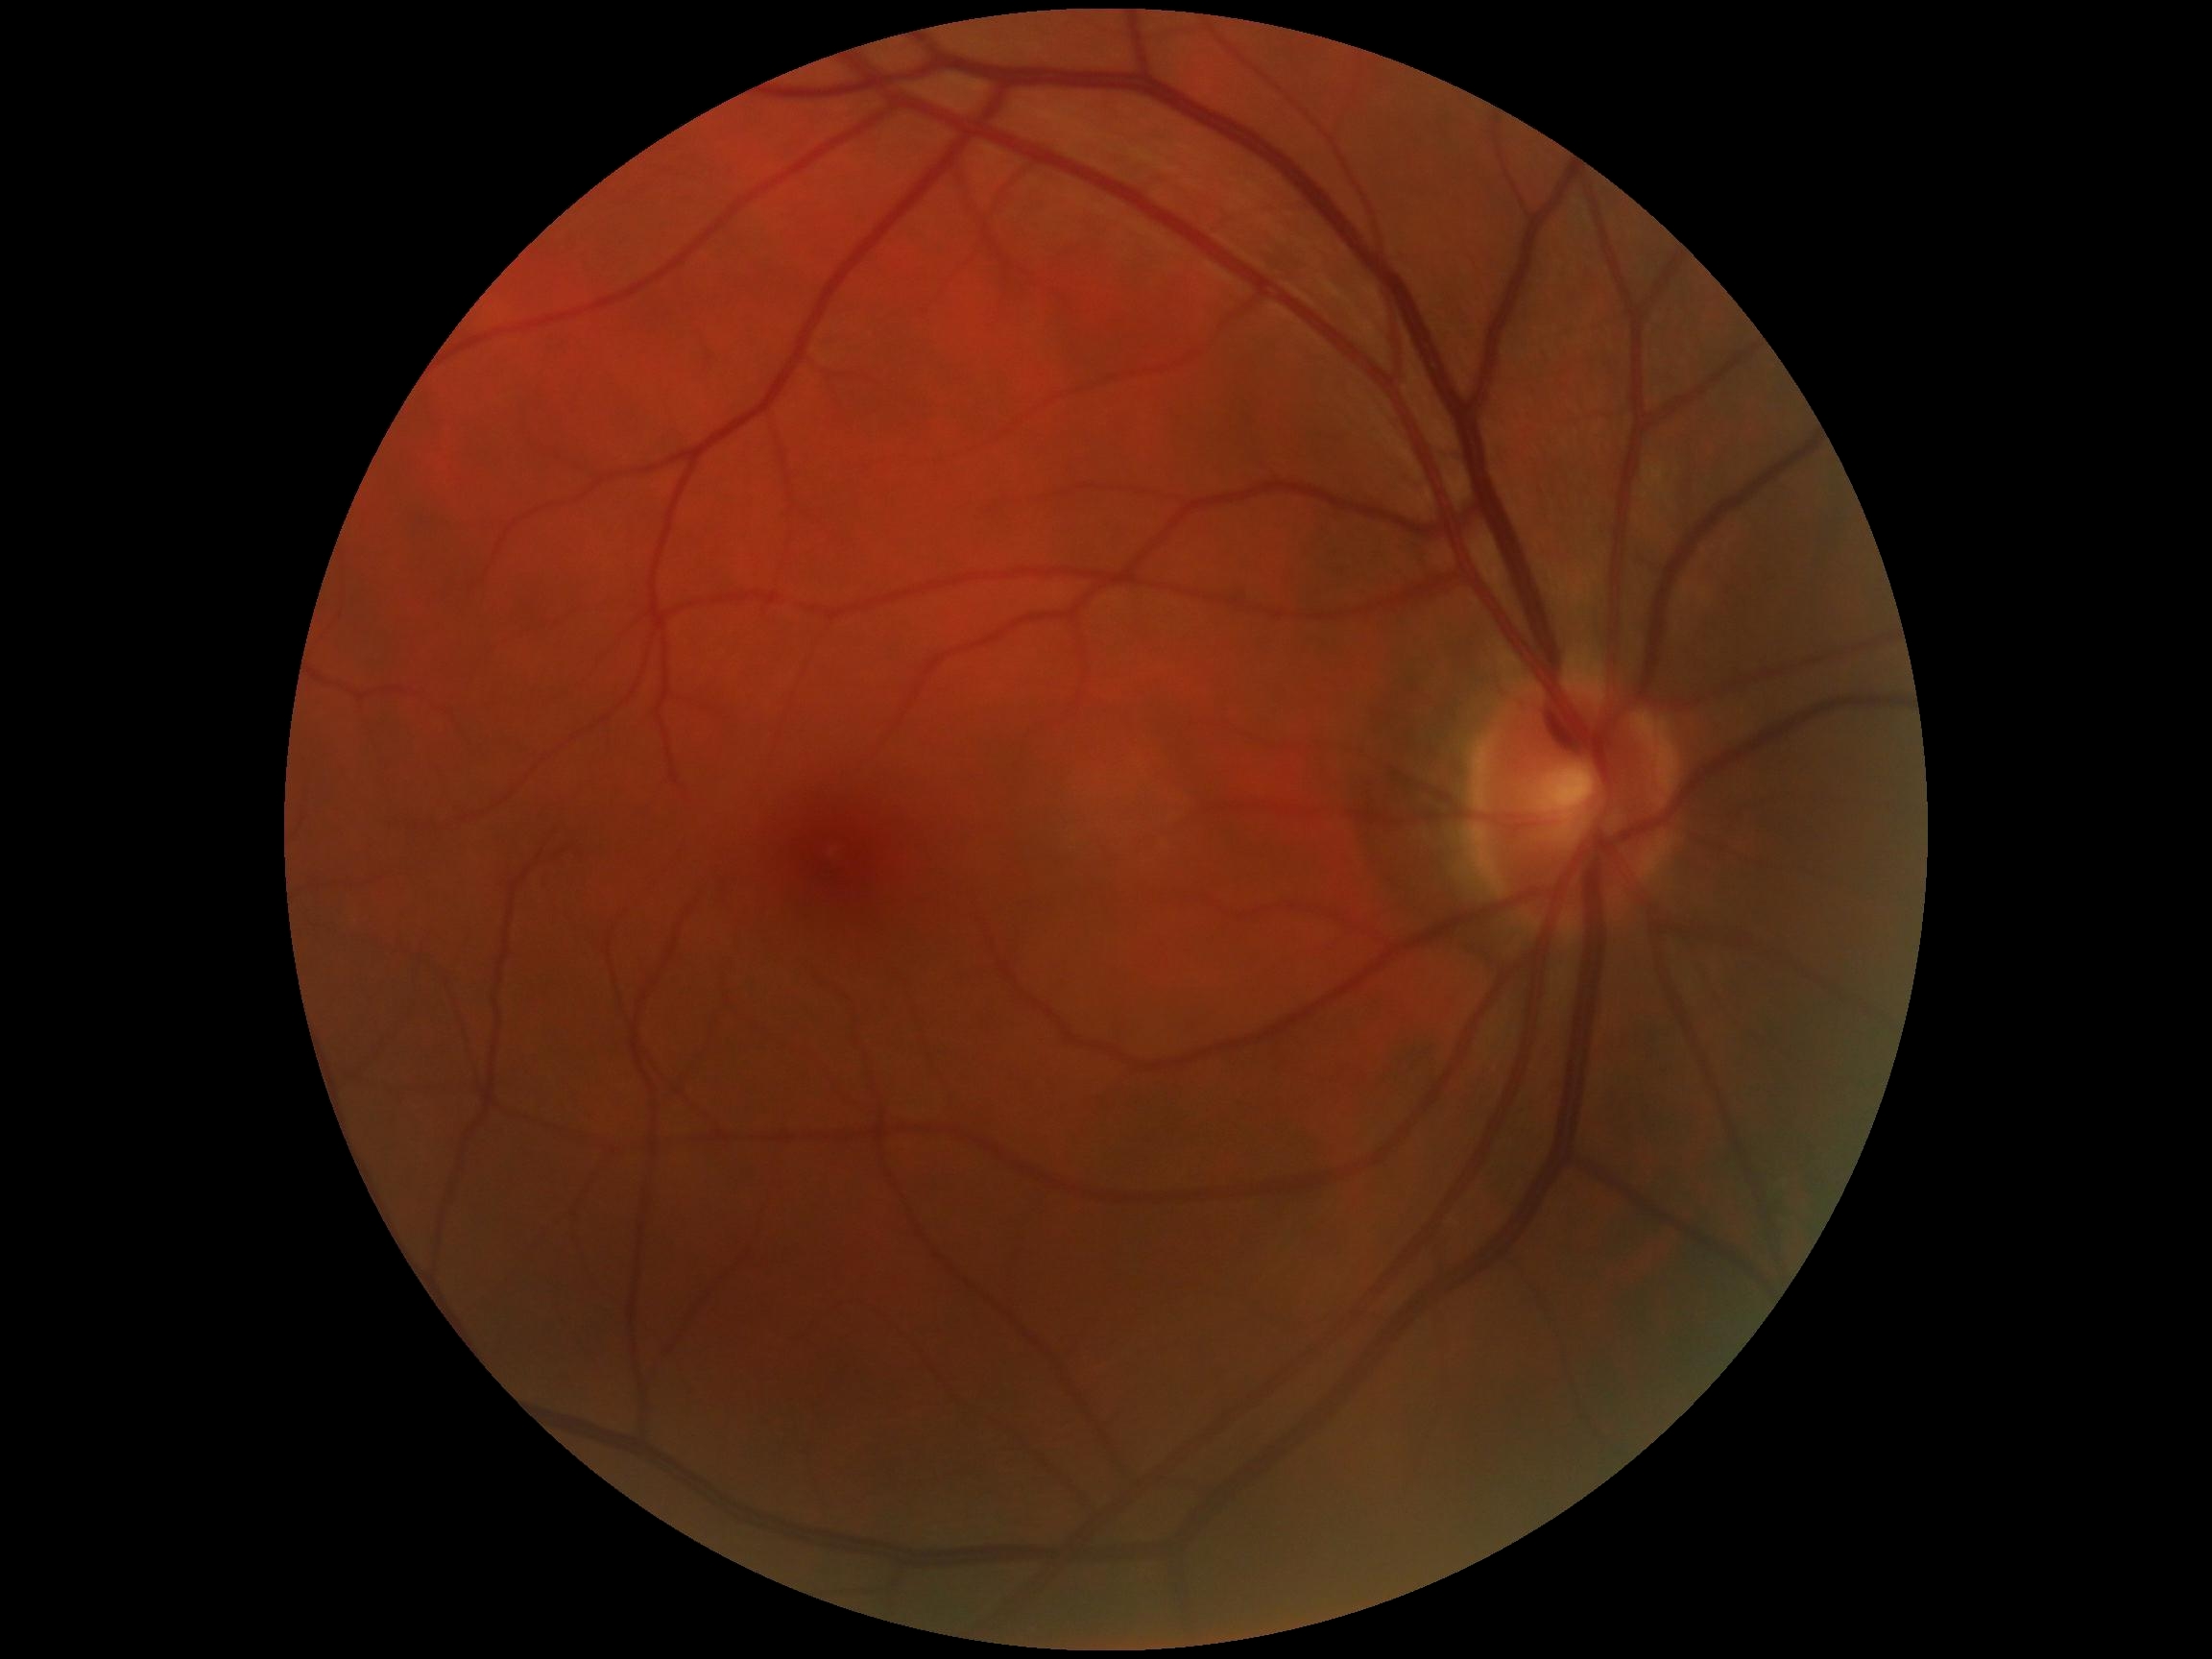 DR is grade 0.